Fundus photo · 45° field of view · 2352x1568px — 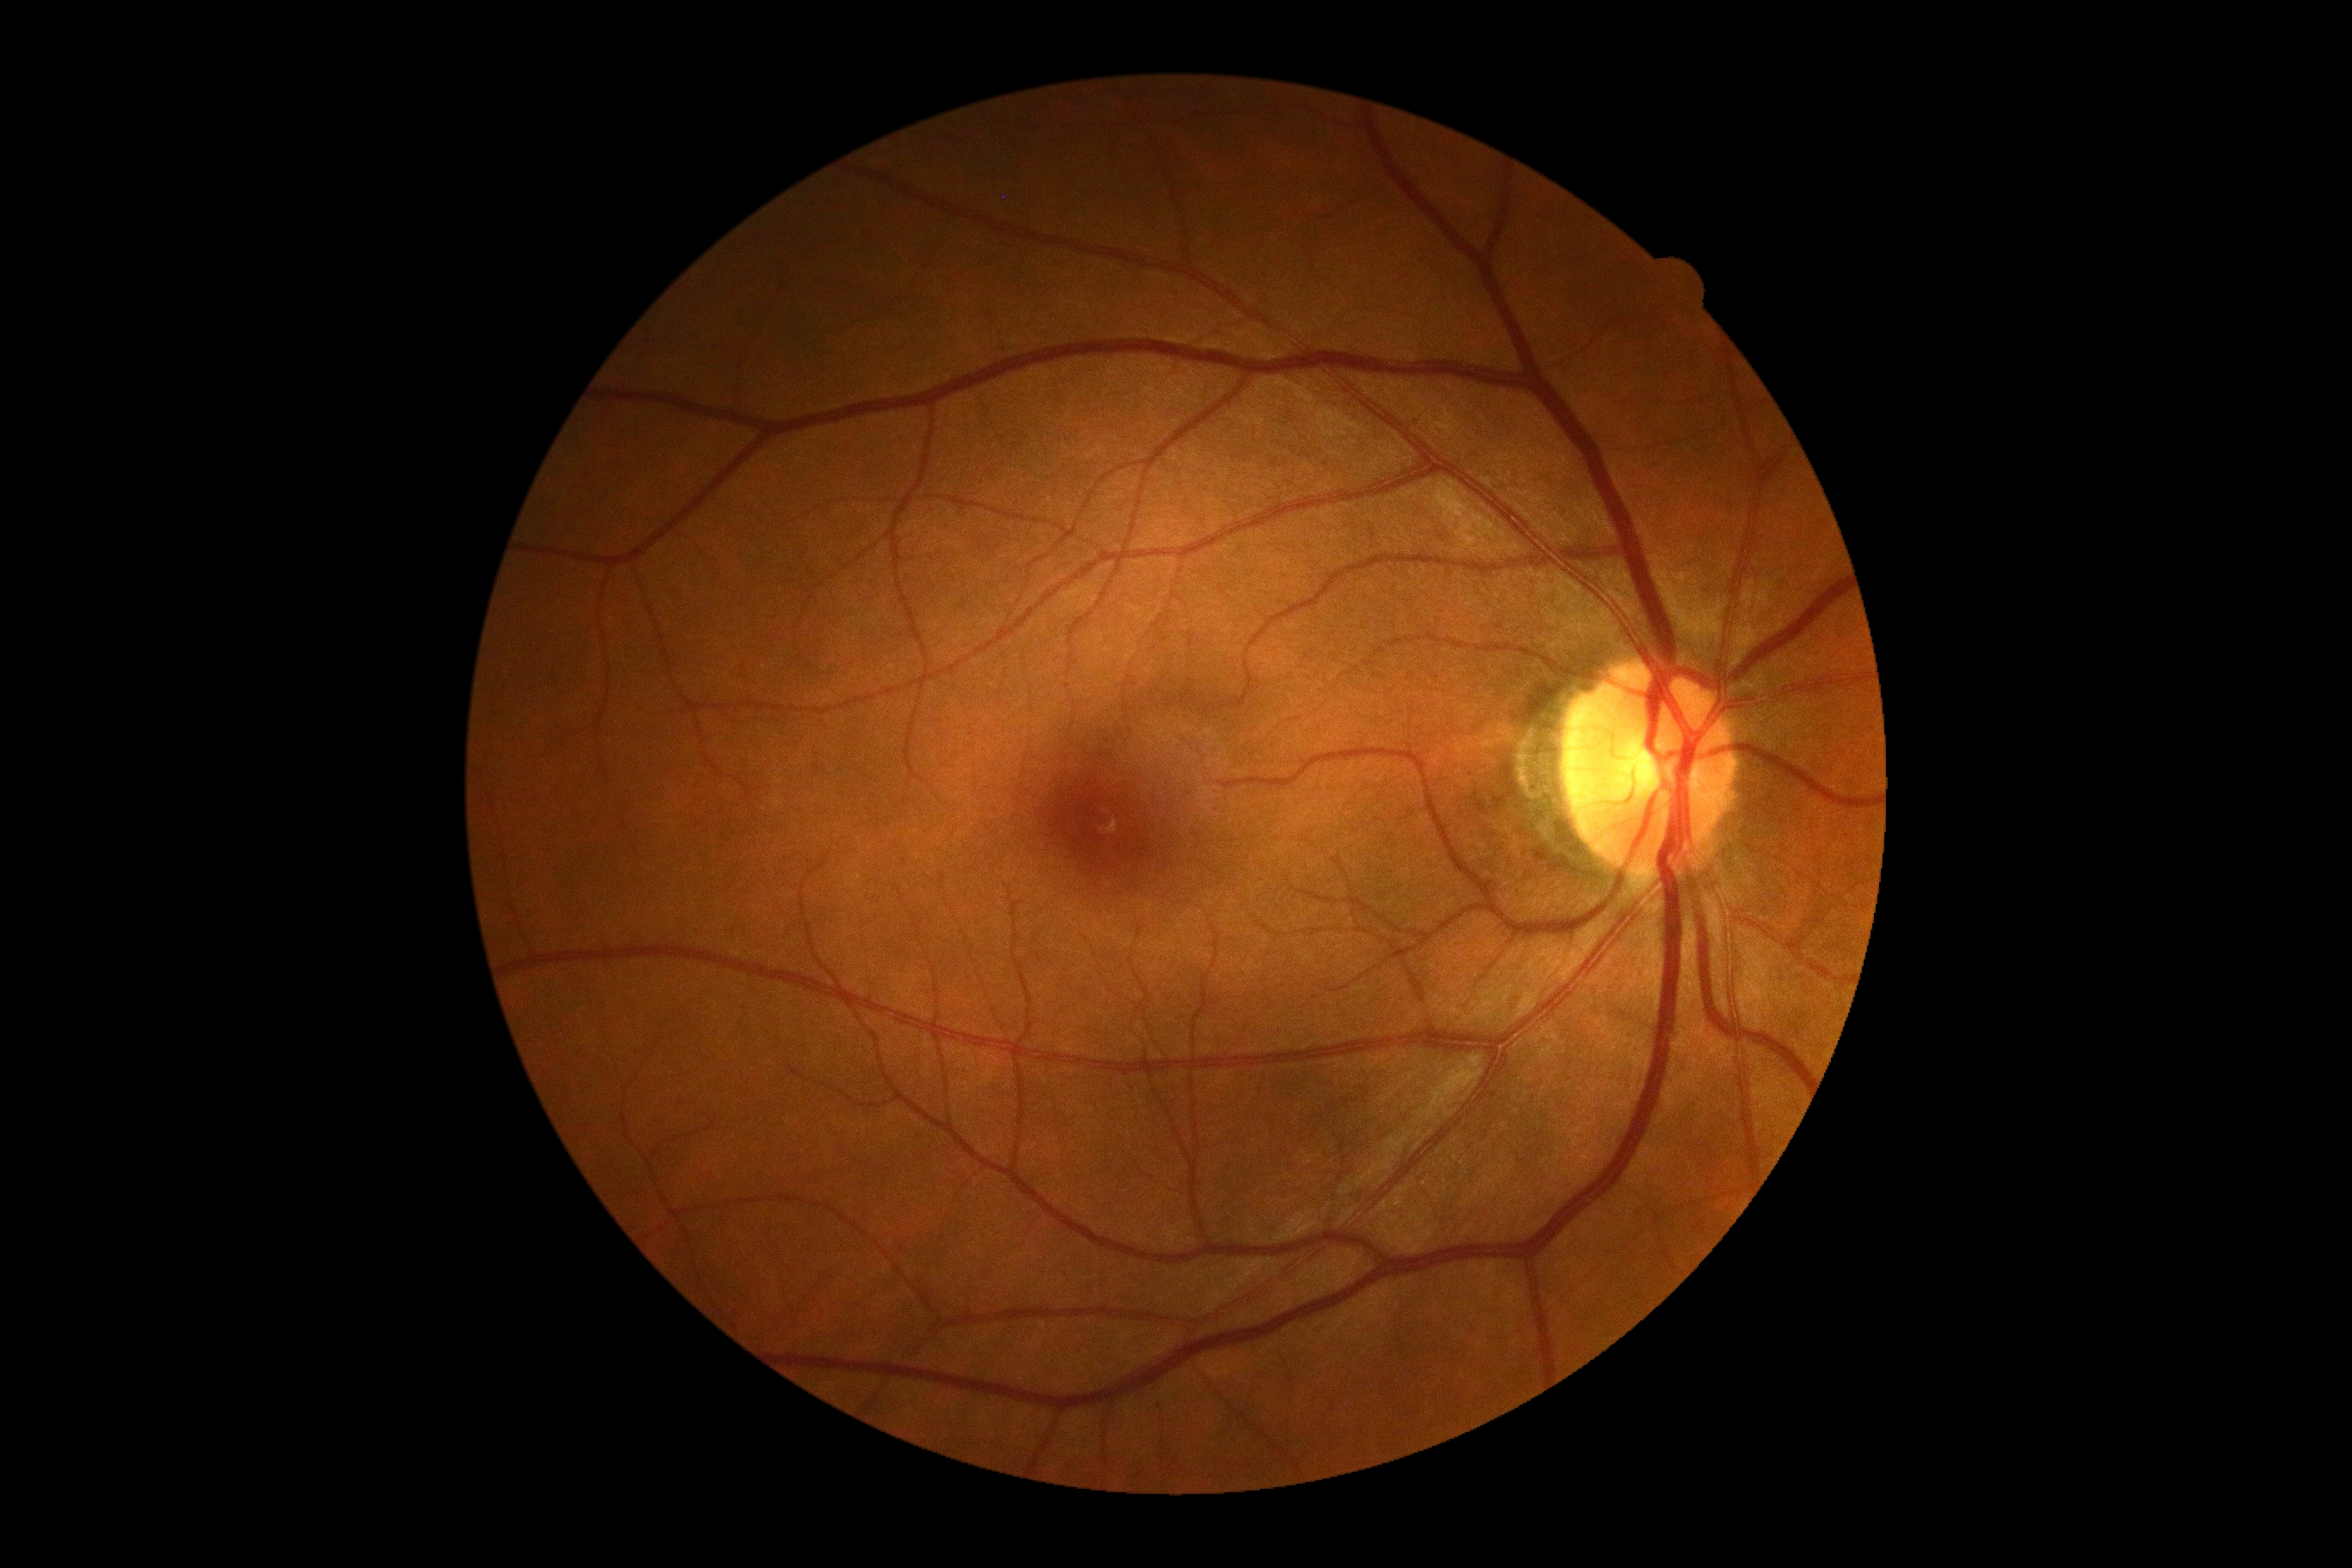 DR grade: 0.